Davis DR grading — 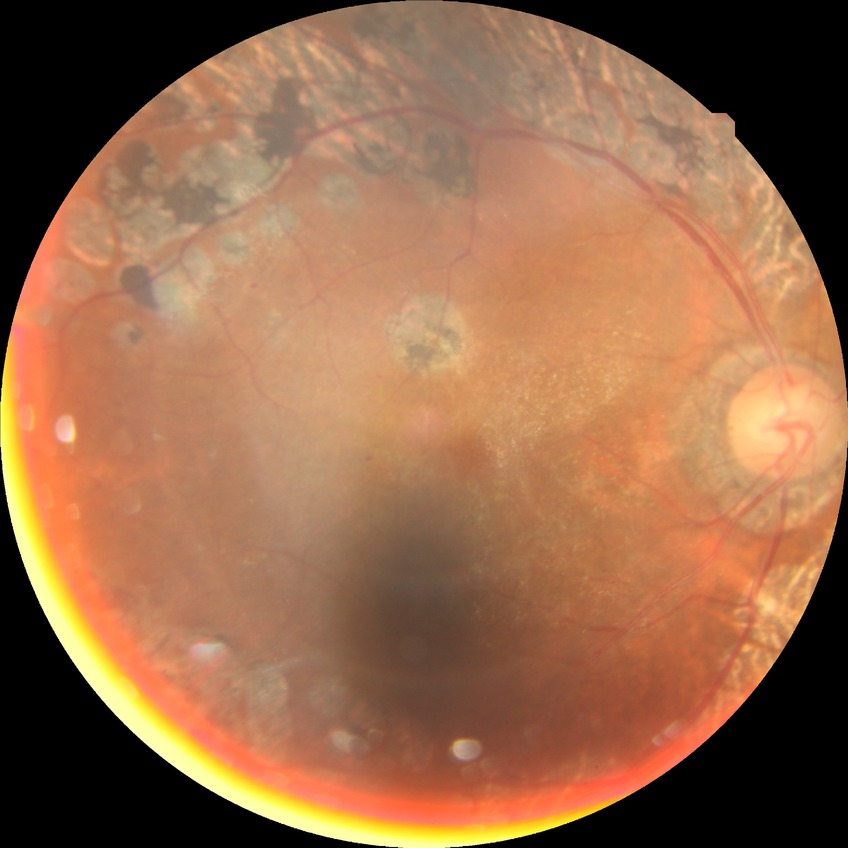

Annotations:
• DR stage — PDR